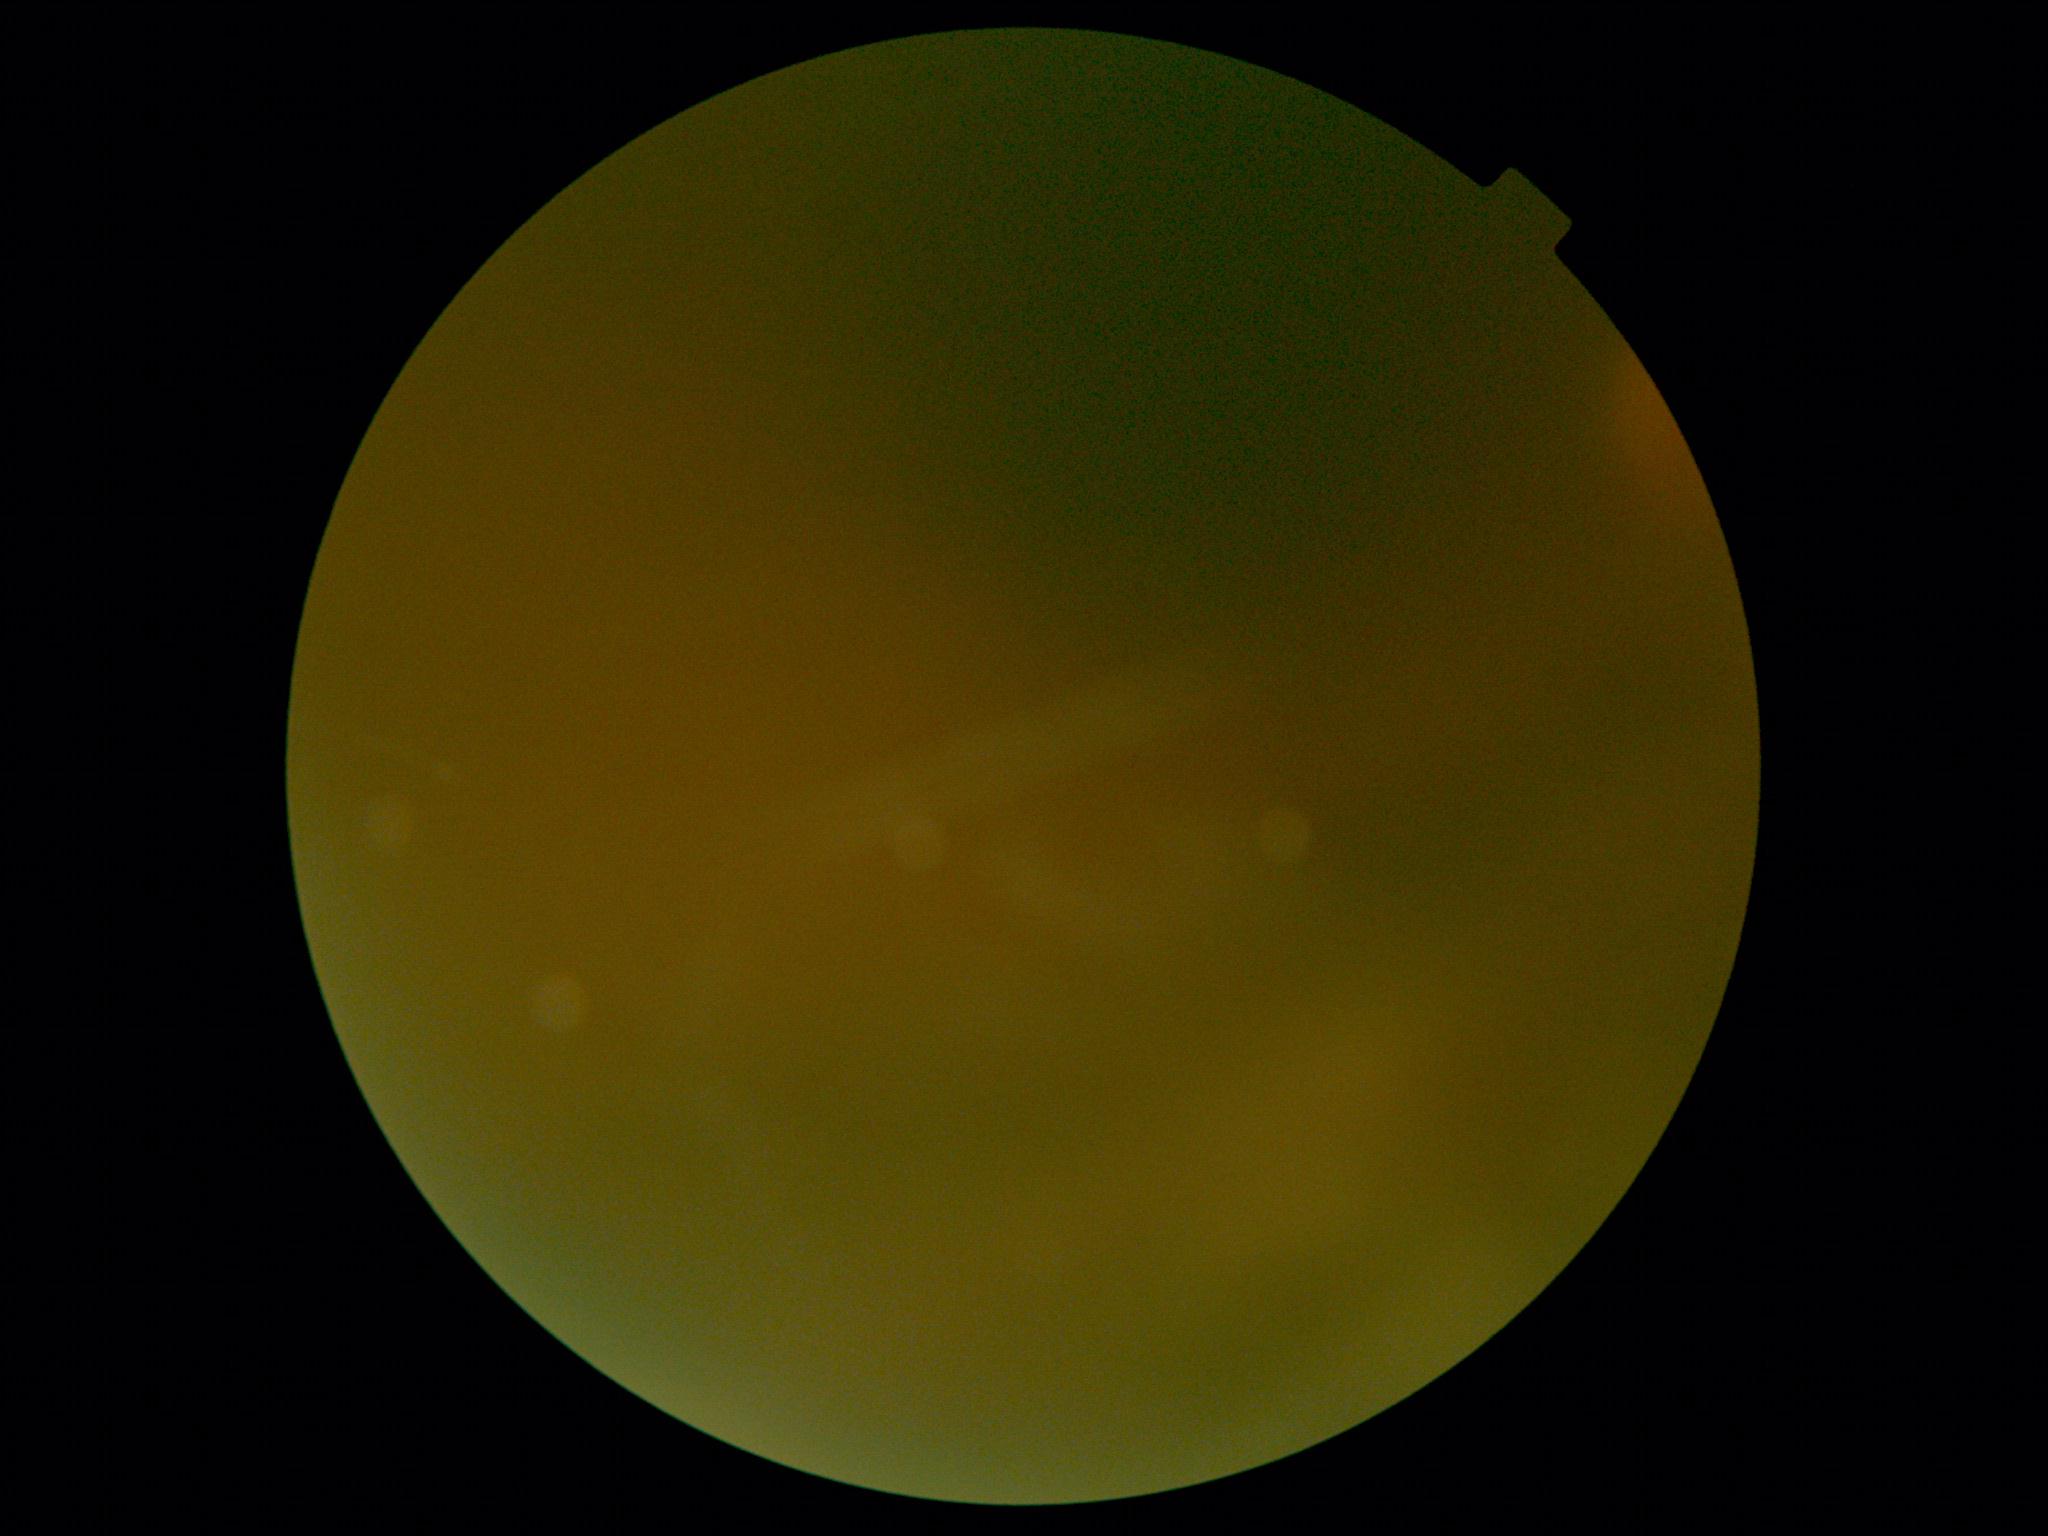 diabetic retinopathy (DR): ungradable due to poor image quality.